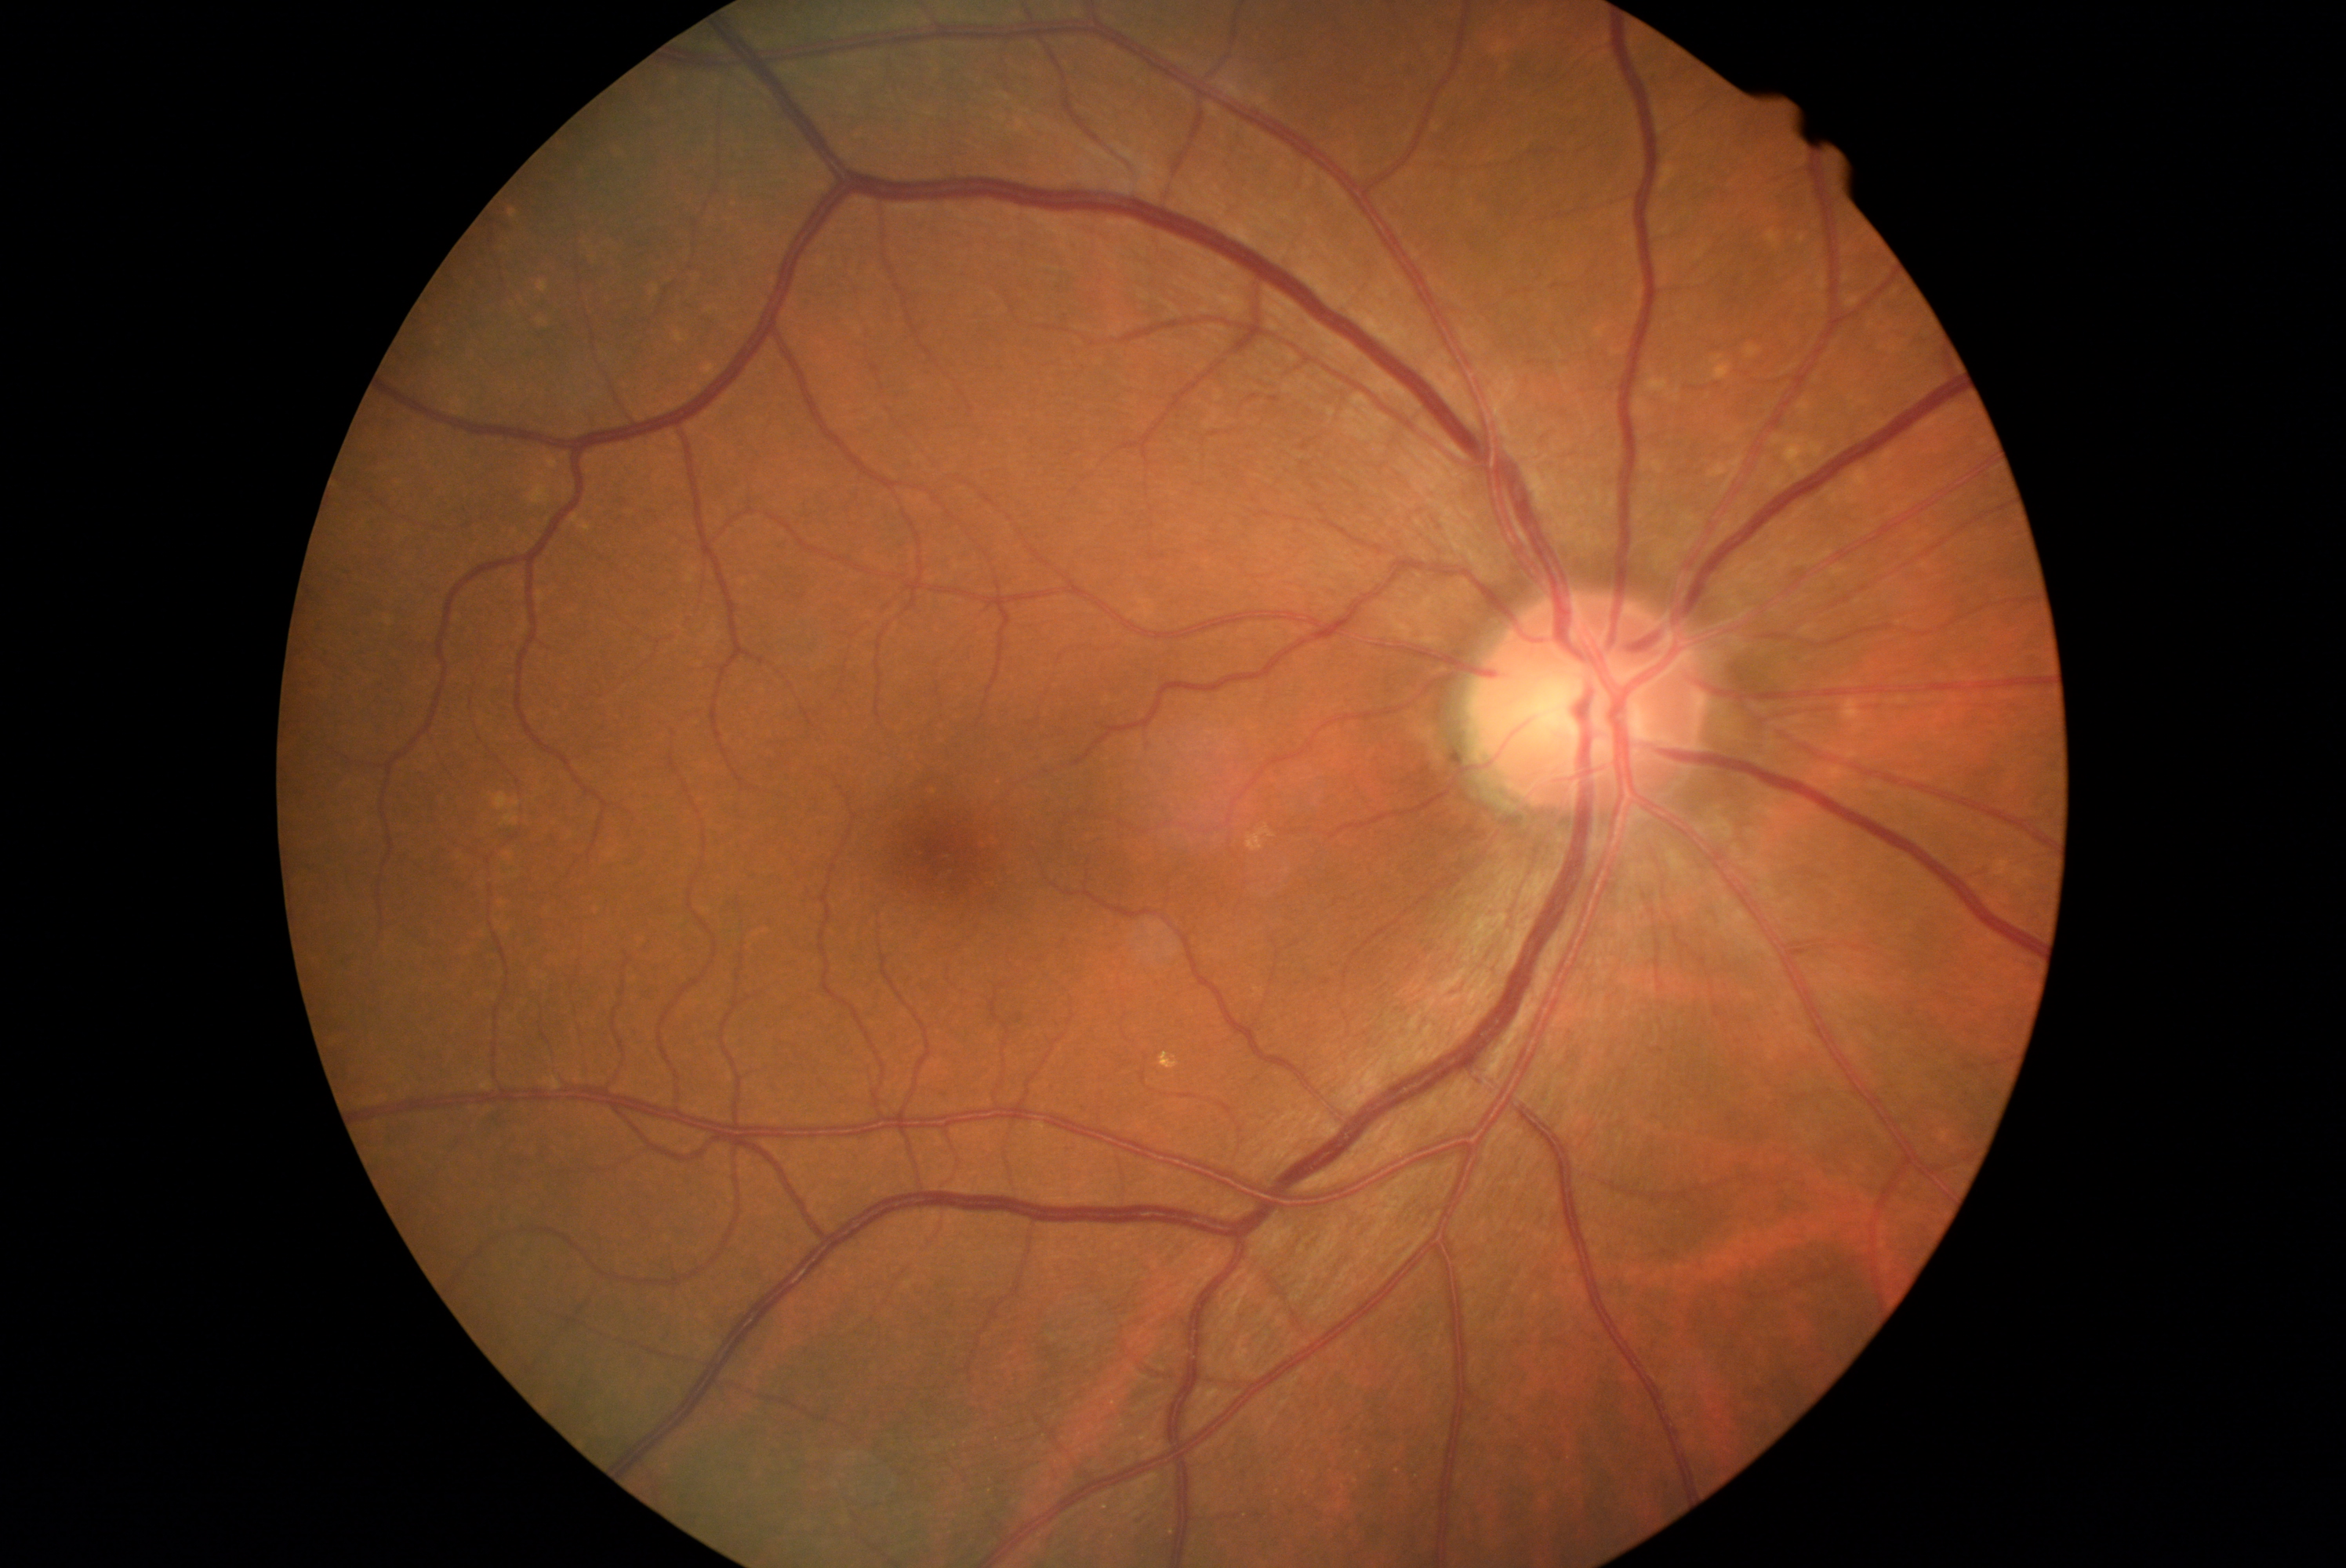
No apparent diabetic retinopathy.
Diabetic retinopathy (DR) is 0/4.